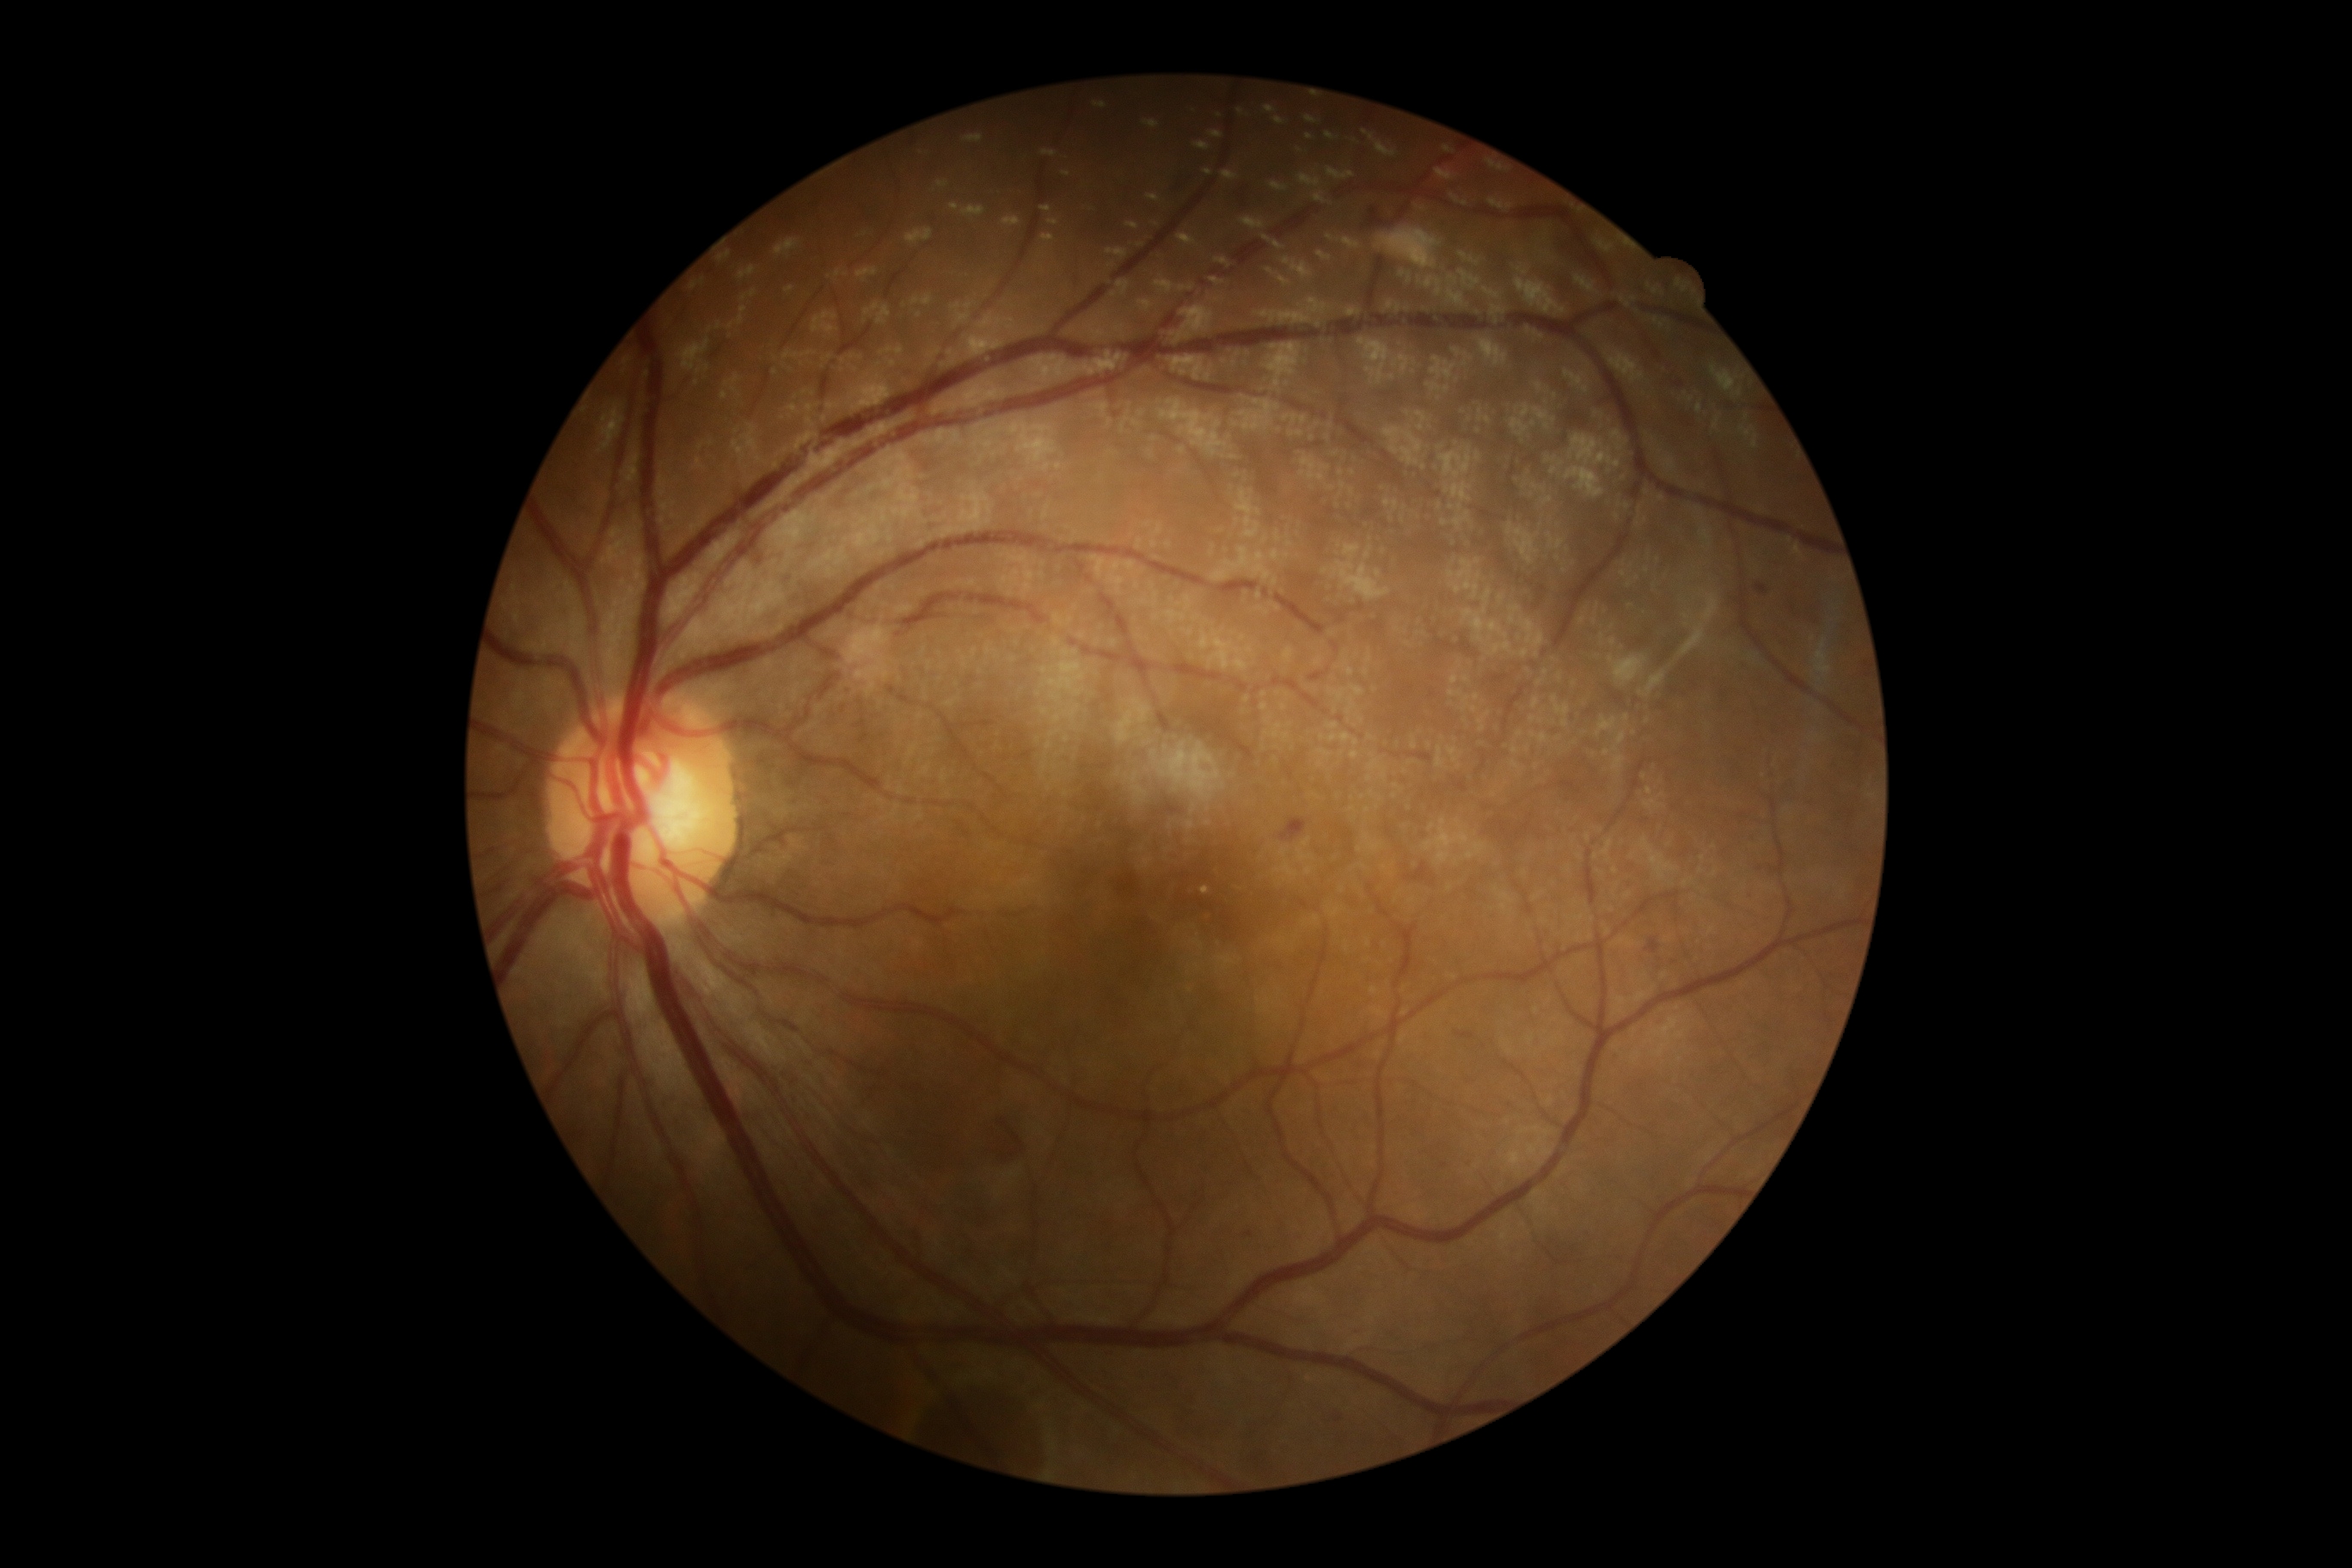 DR grade: 2/4
HEs: <bbox>1368, 209, 1385, 228</bbox> | <bbox>1280, 819, 1308, 840</bbox> | <bbox>1404, 862, 1430, 881</bbox> | <bbox>1333, 1414, 1344, 1423</bbox> | <bbox>1118, 874, 1139, 897</bbox> | <bbox>1646, 940, 1660, 955</bbox>
EXs: <bbox>1141, 859, 1155, 869</bbox>
MAs: <bbox>1755, 584, 1768, 596</bbox> | <bbox>1244, 1232, 1254, 1239</bbox>
Smaller MAs around 1749/895 | 1445/1165 | 1357/1330
SEs: not present